Captured after pupil dilation.
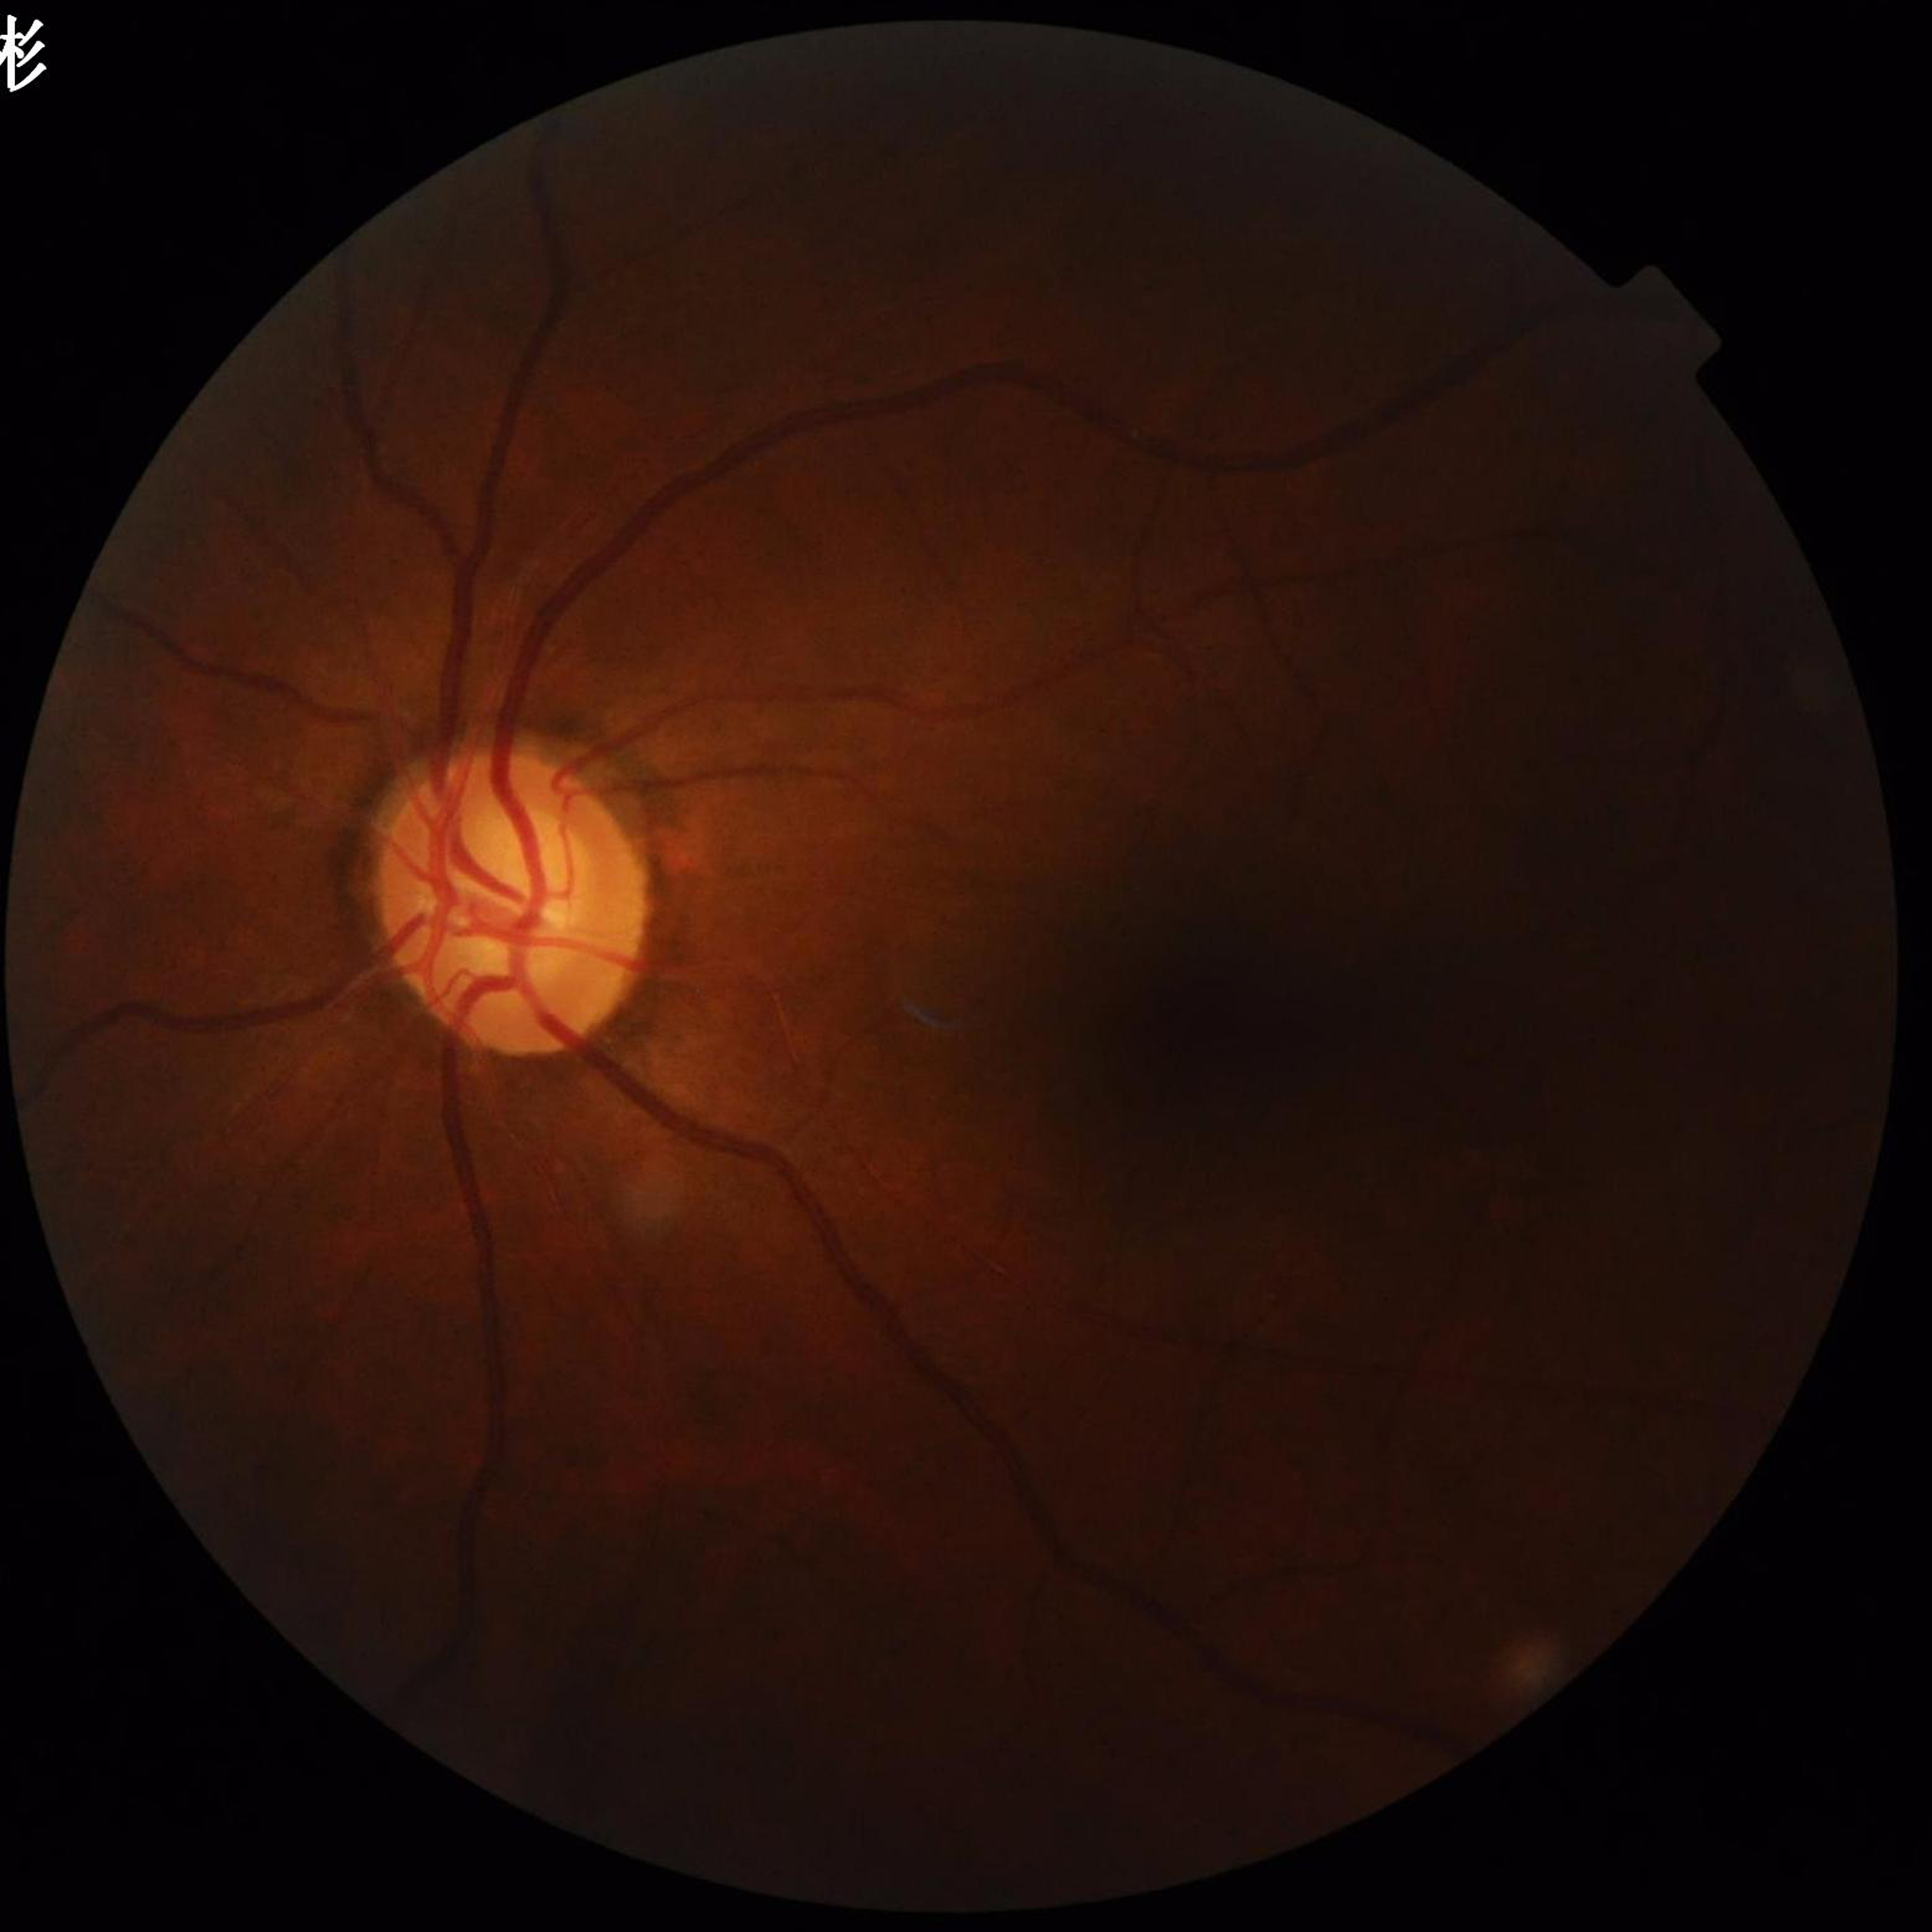
Disease = glaucoma
Image quality = no blur, illumination/color distortion present, contrast adequate